45° FOV — 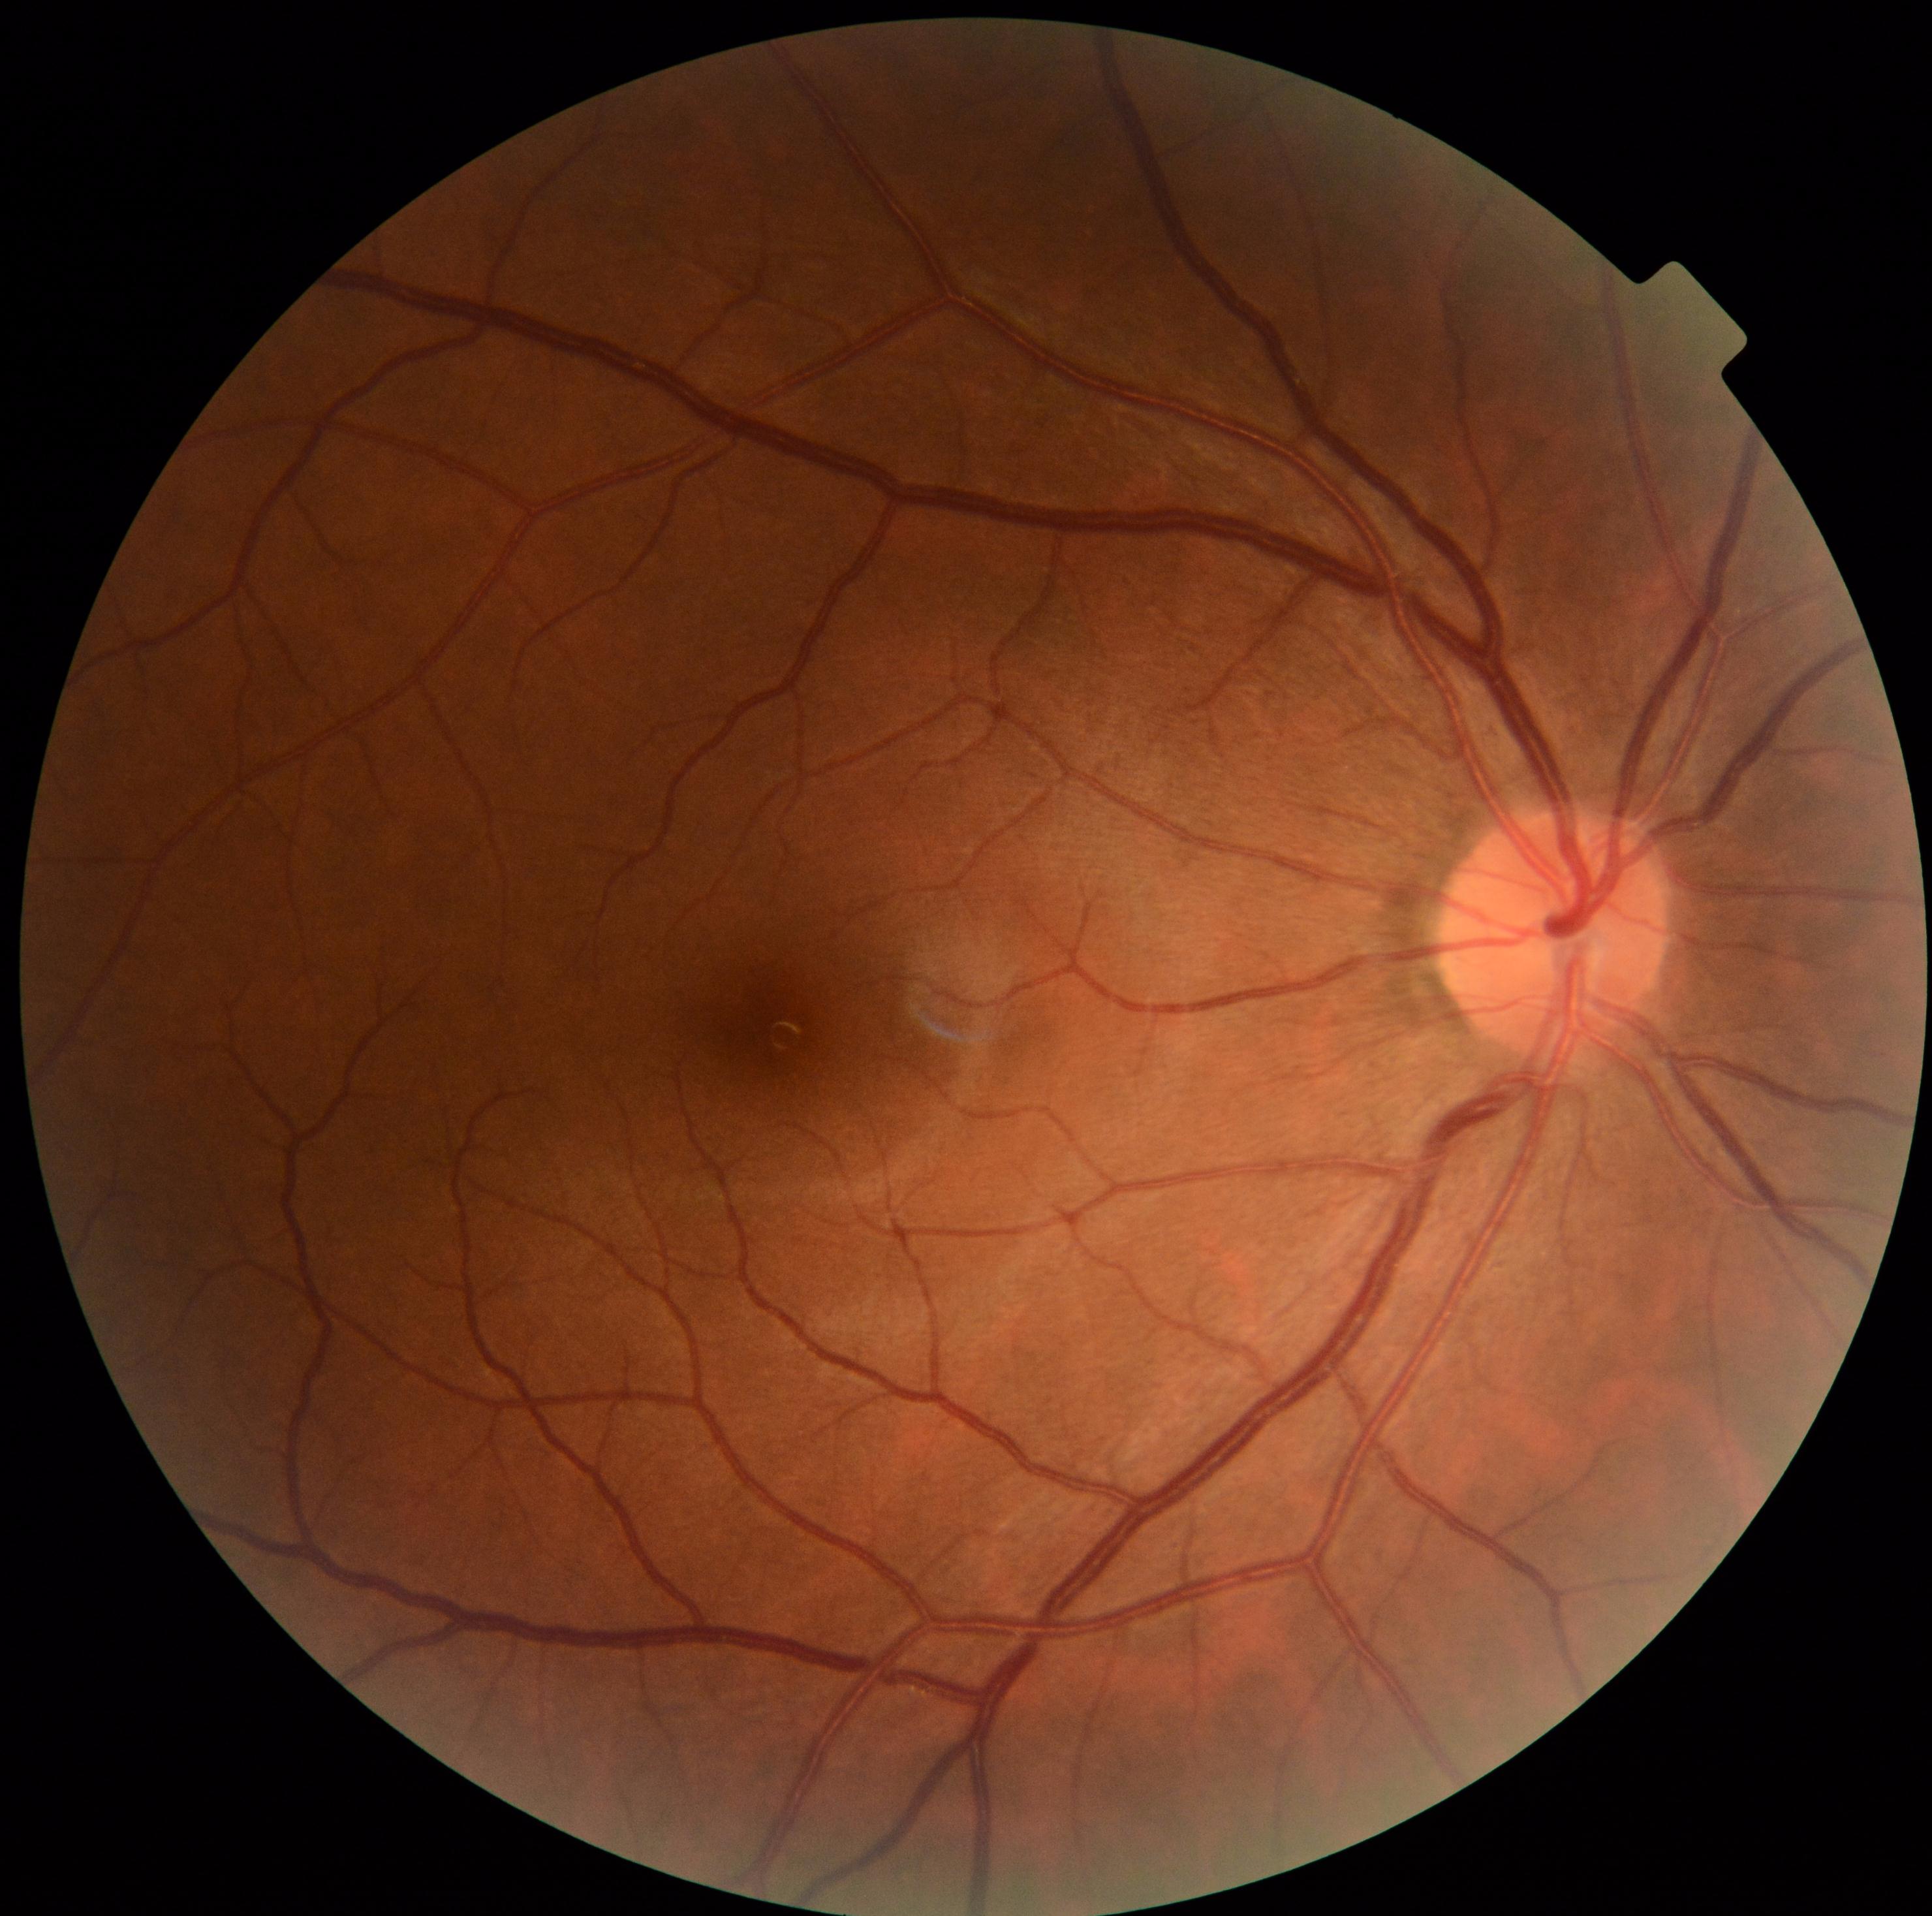
DR grade is 0.
No diabetic retinal disease findings.